Wide-field fundus image from infant ROP screening; Phoenix ICON, 100° FOV — 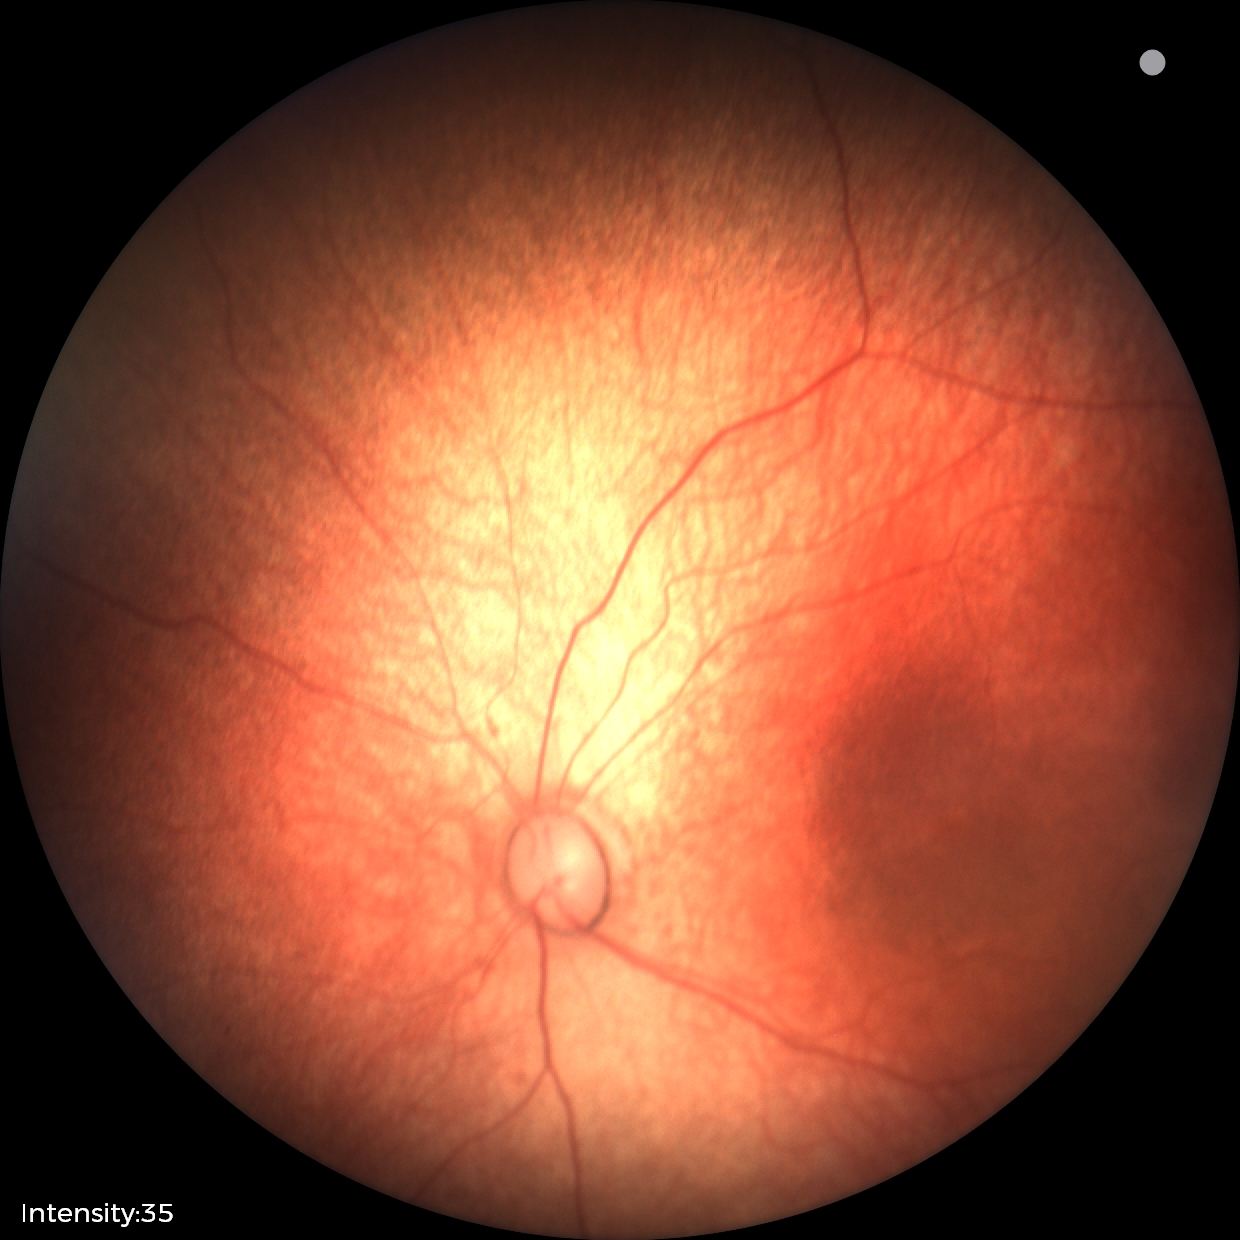
Examination with physiological retinal findings.